Retinal fundus photograph; 1380x1382.
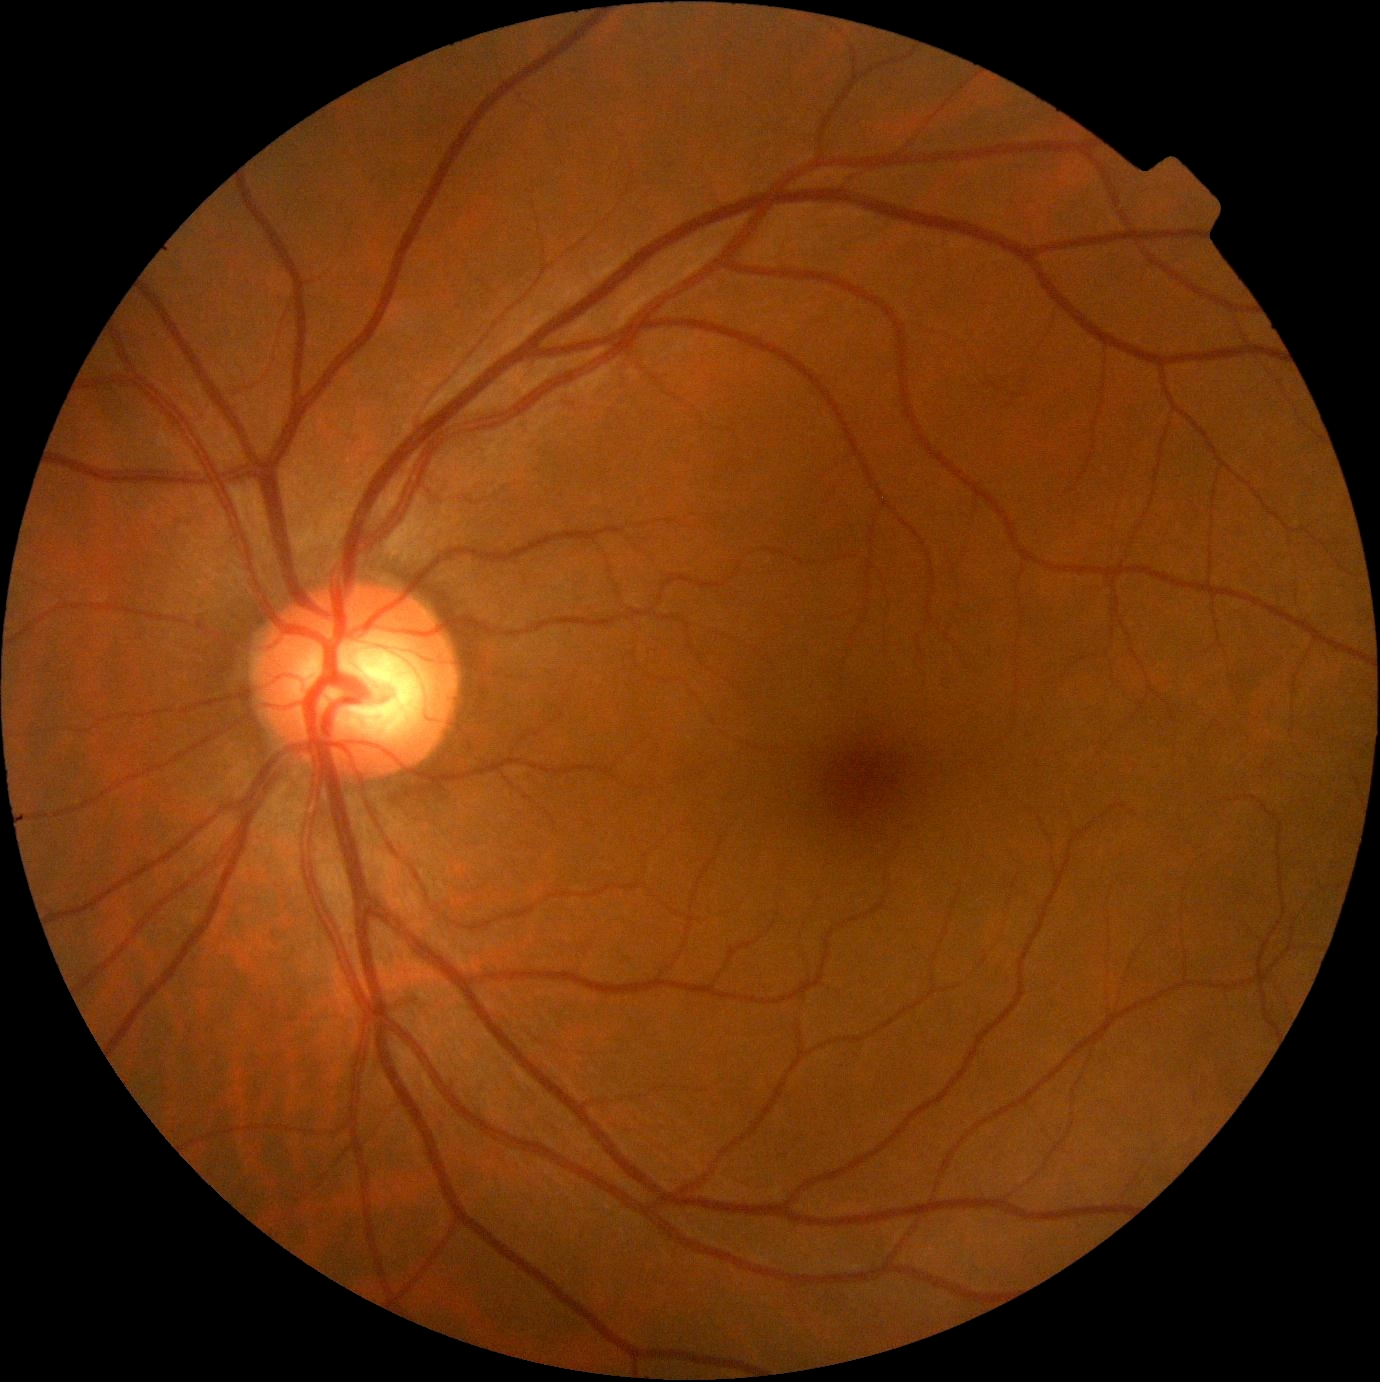 DR severity: 0 | DR impression: no signs of DR.